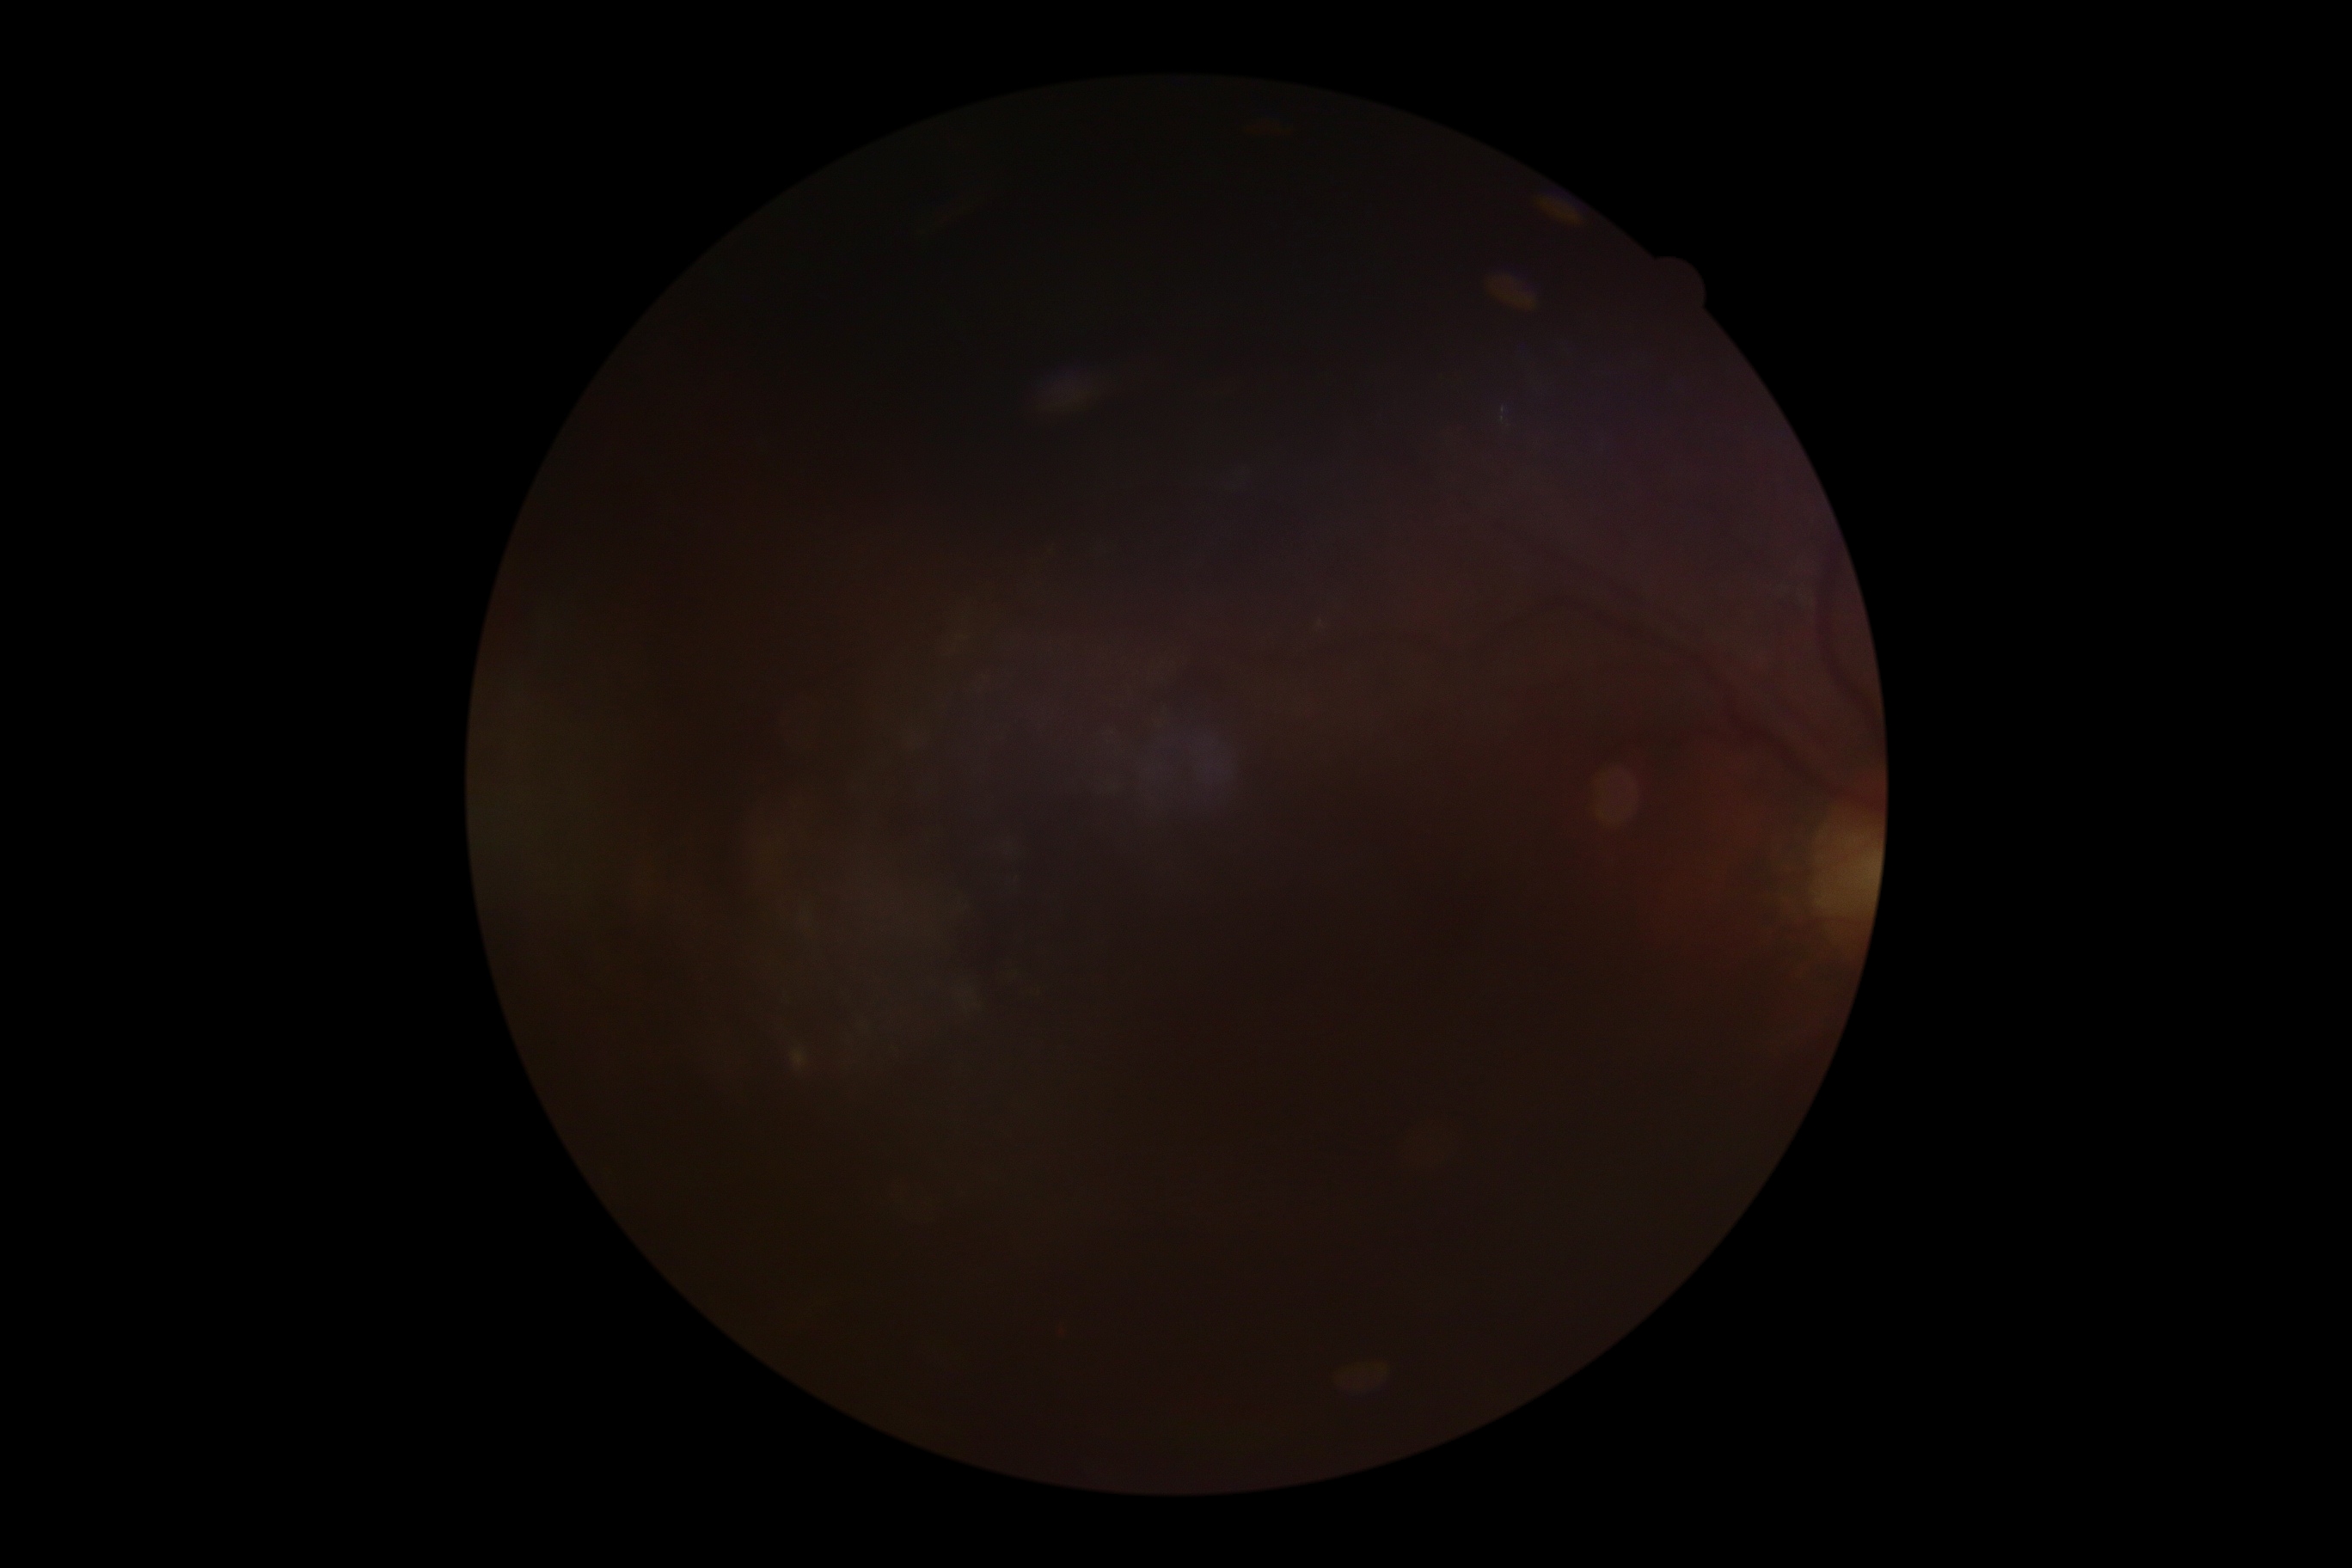
Ungradable image — DR severity cannot be determined. DR severity: ungradable due to poor image quality.